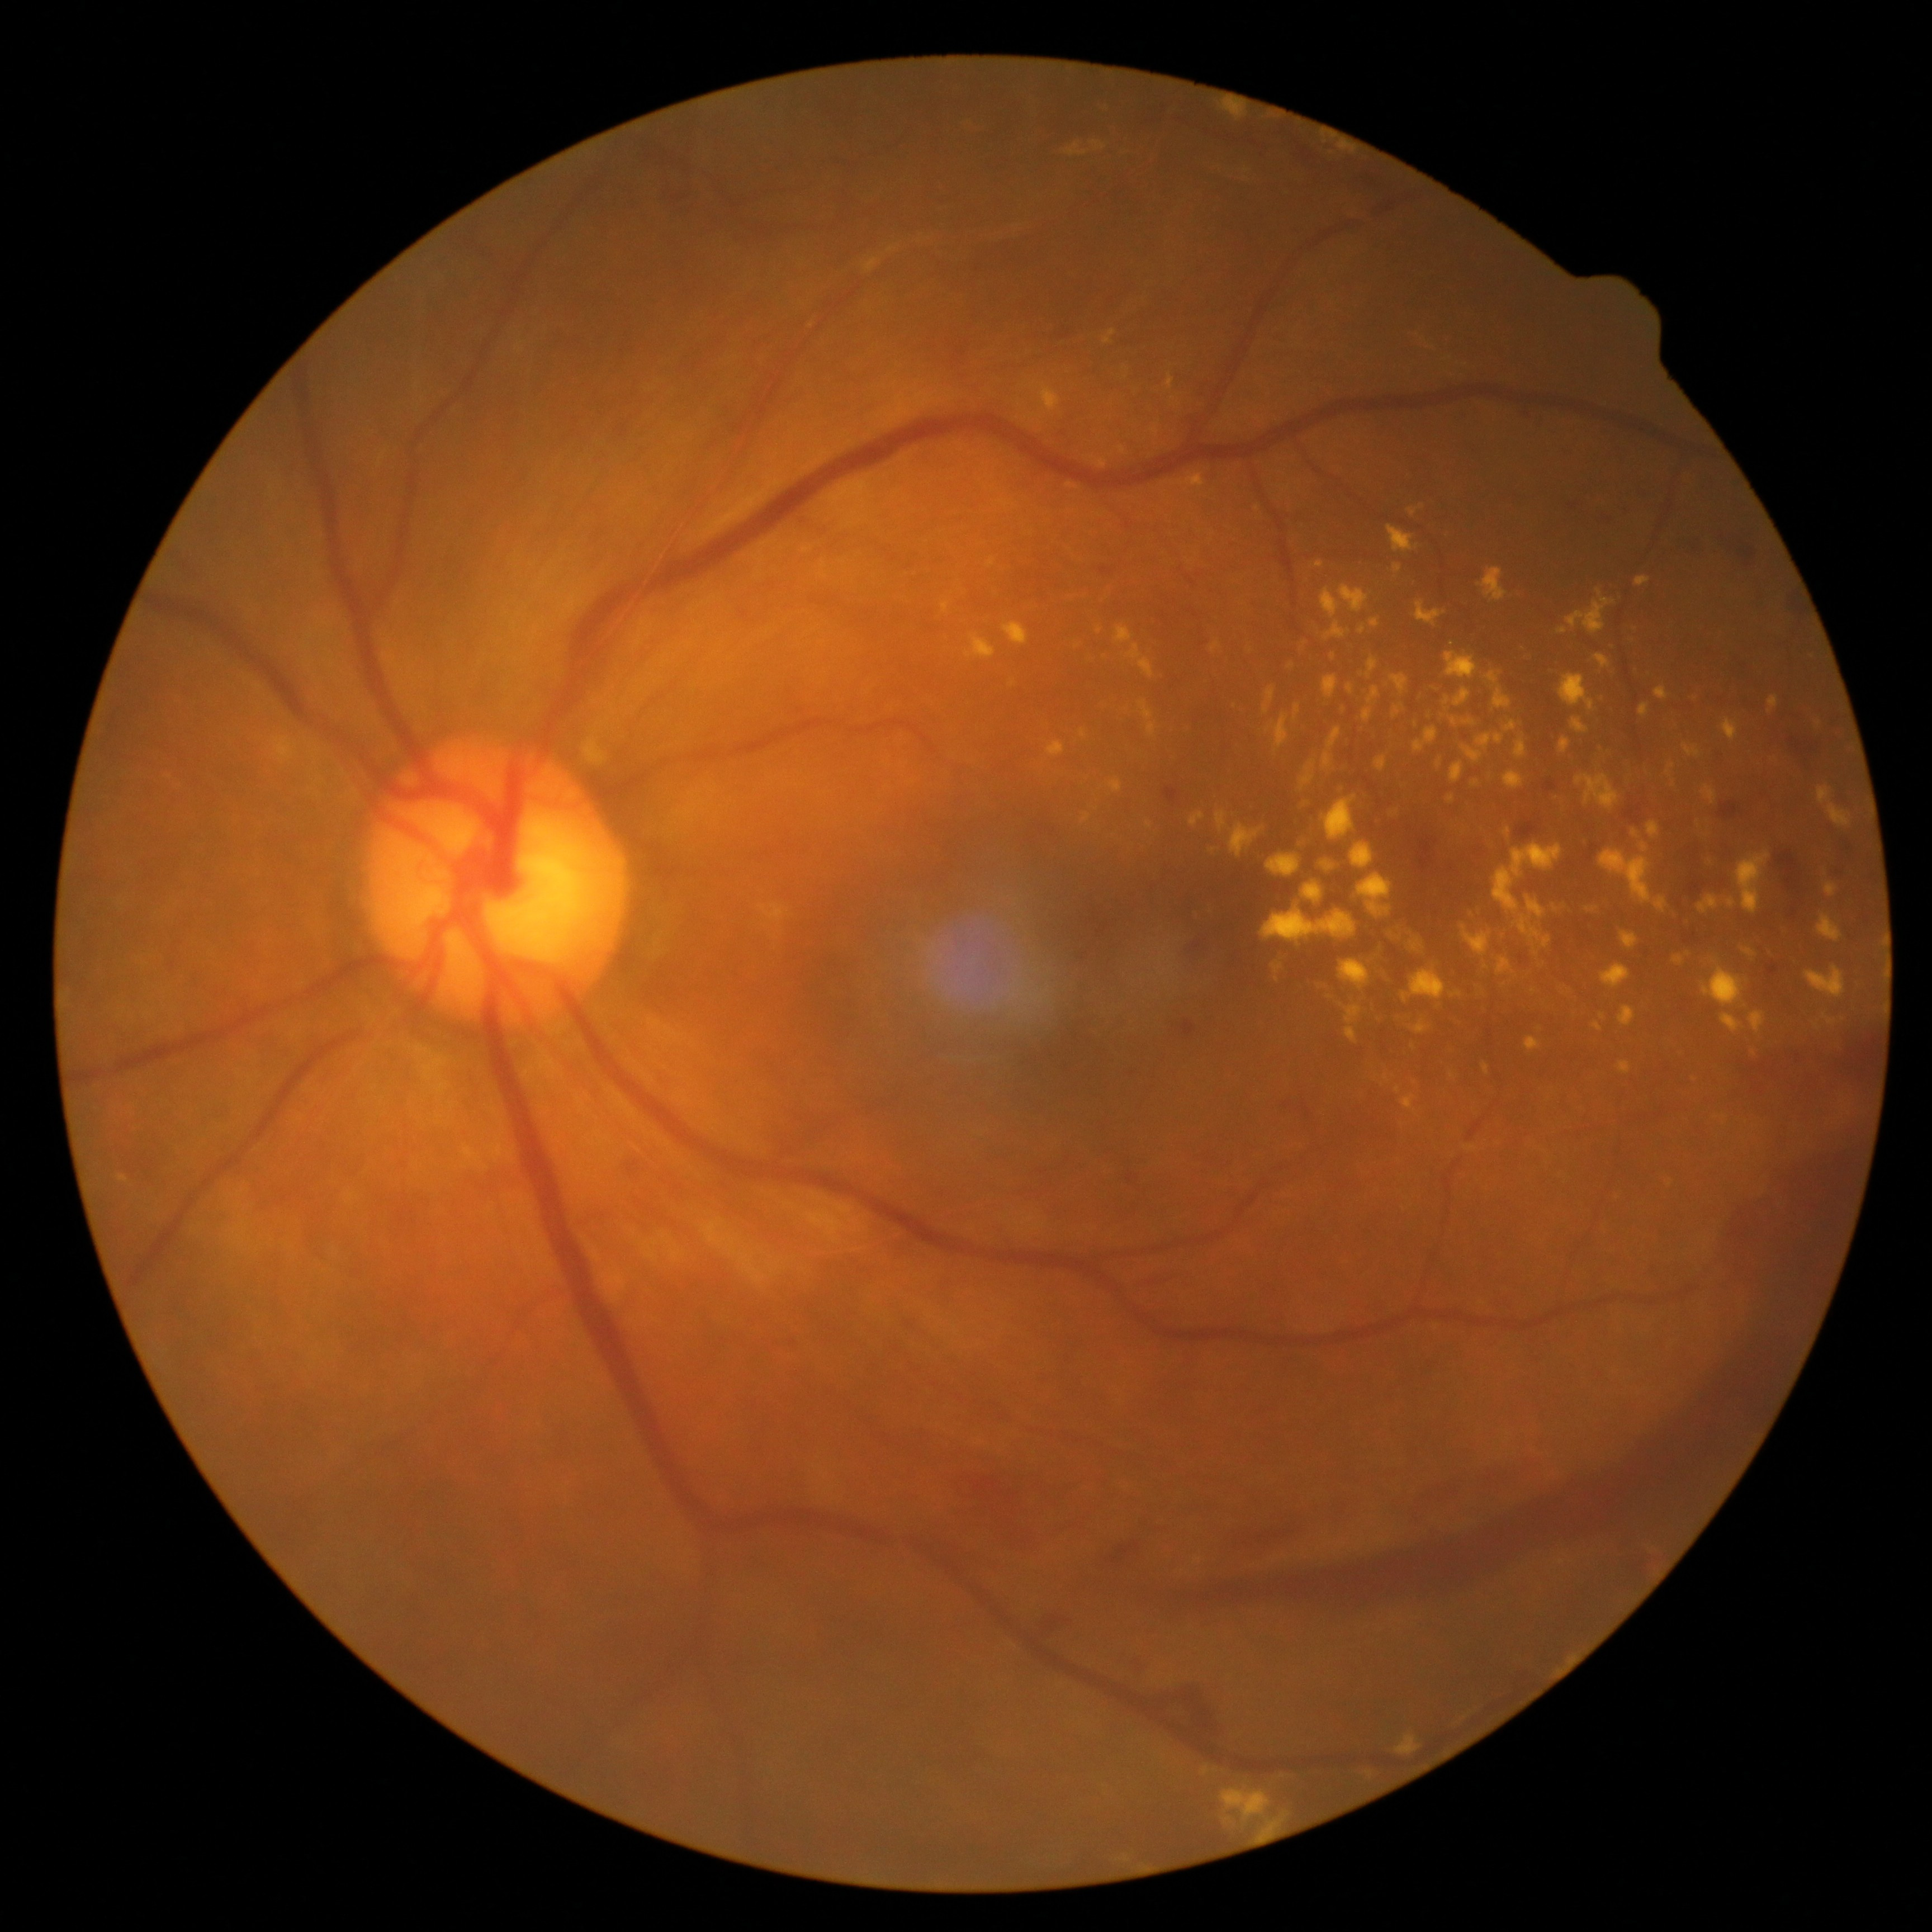 Retinopathy grade is 4/4.
Hard exudates include those at box=[1147, 821, 1152, 830], box=[1262, 908, 1357, 943], box=[1570, 718, 1589, 735], box=[1461, 925, 1492, 958], box=[1720, 718, 1738, 742], box=[1366, 657, 1378, 679], box=[1727, 898, 1736, 910], box=[1103, 330, 1116, 345], box=[1167, 373, 1176, 392], box=[1359, 624, 1366, 634], box=[1443, 695, 1451, 712], box=[1632, 828, 1640, 839], box=[1415, 727, 1437, 753], box=[1454, 688, 1472, 708], box=[1602, 964, 1632, 990], box=[1526, 1037, 1542, 1052], box=[1401, 969, 1447, 1002].
Small hard exudates near pt(1288, 488), pt(1213, 849), pt(1723, 1118).